848x848. NIDEK AFC-230 fundus camera
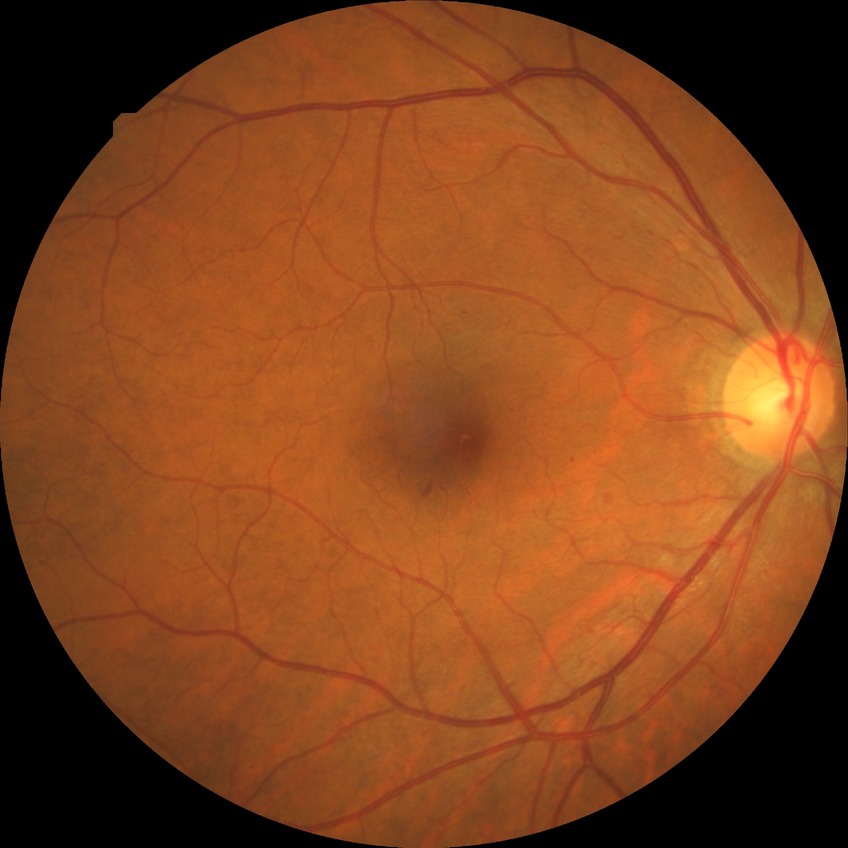
Annotations:
* modified Davis grading — simple diabetic retinopathy